45° FOV.
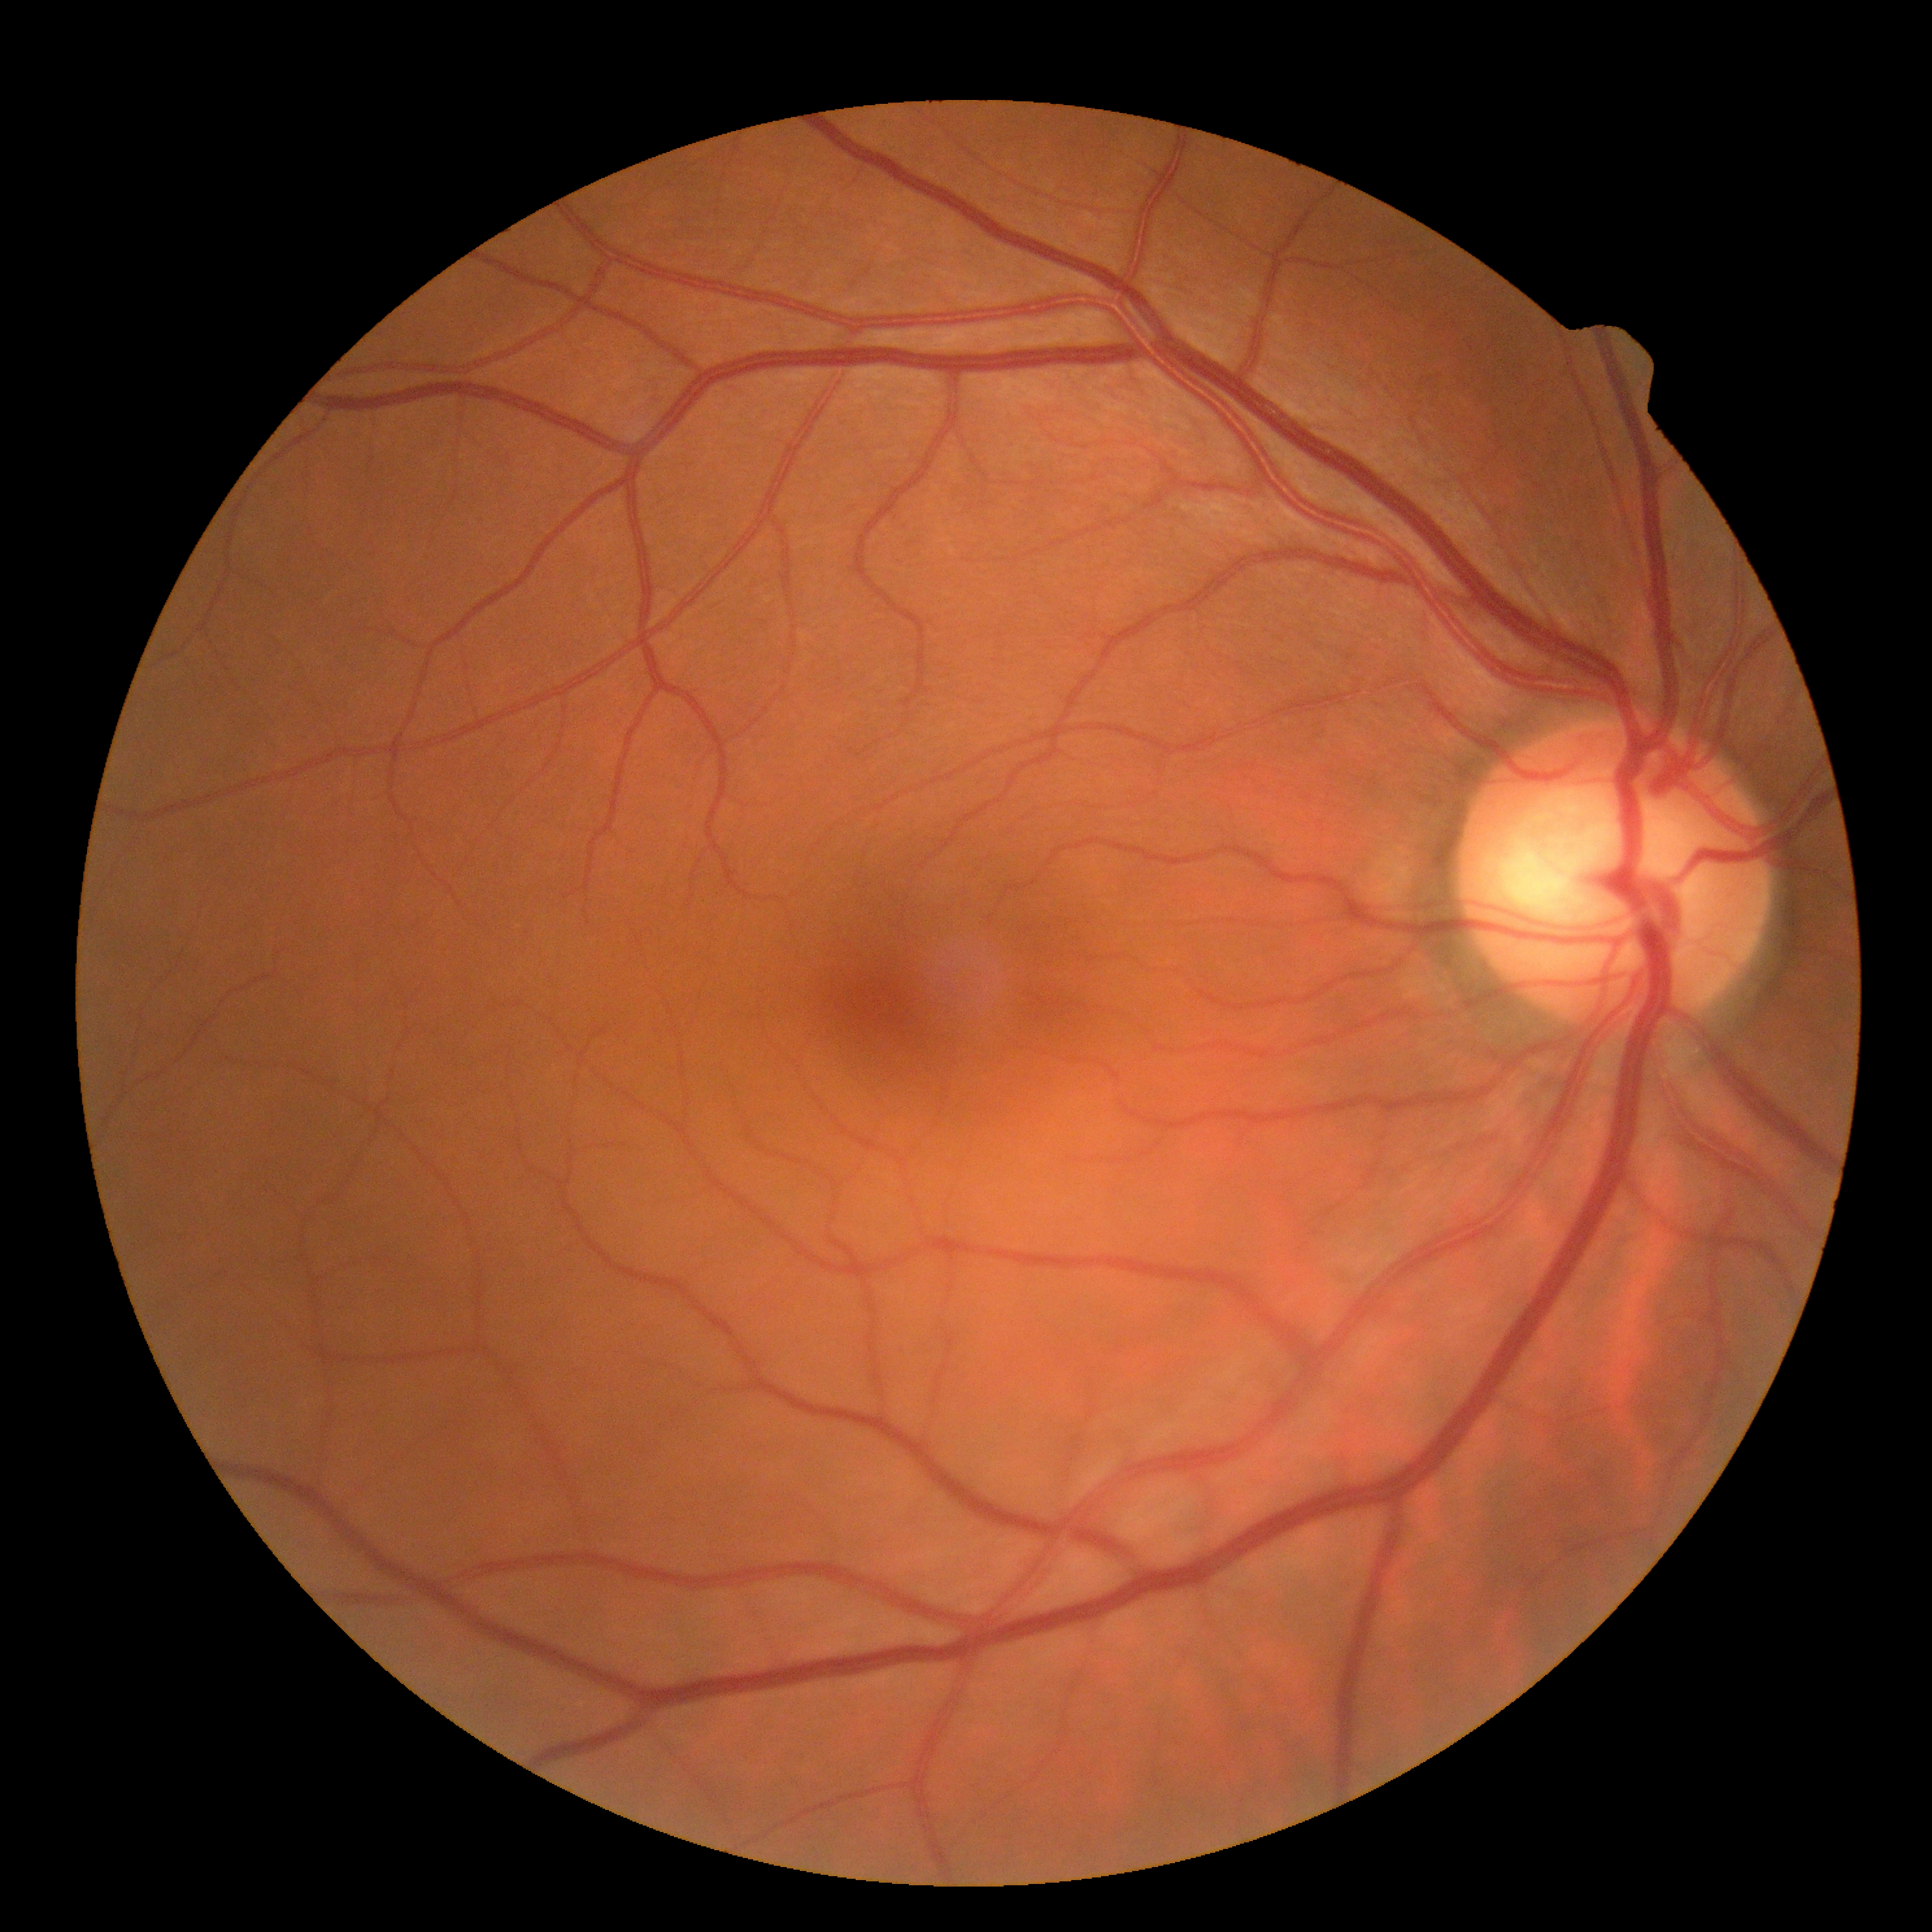 – diabetic retinopathy (DR): 0 — no visible signs of diabetic retinopathy